Fundus photograph cropped around the optic nerve head
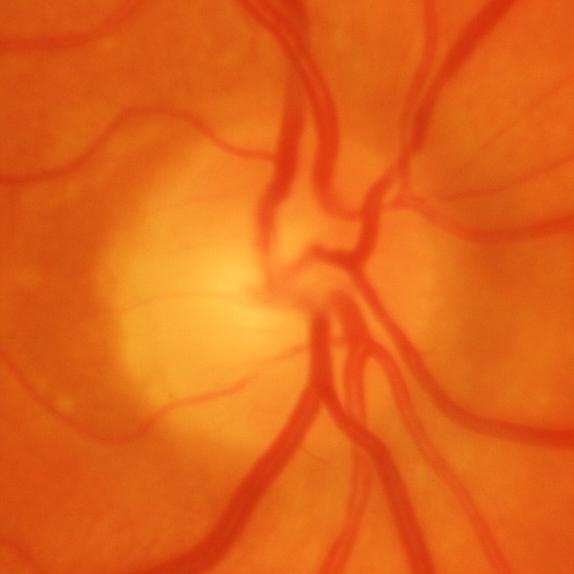 Q: Glaucoma assessment?
A: Glaucomatous damage to the optic nerve.